Infant wide-field fundus photograph; 1240 x 1240 pixels:
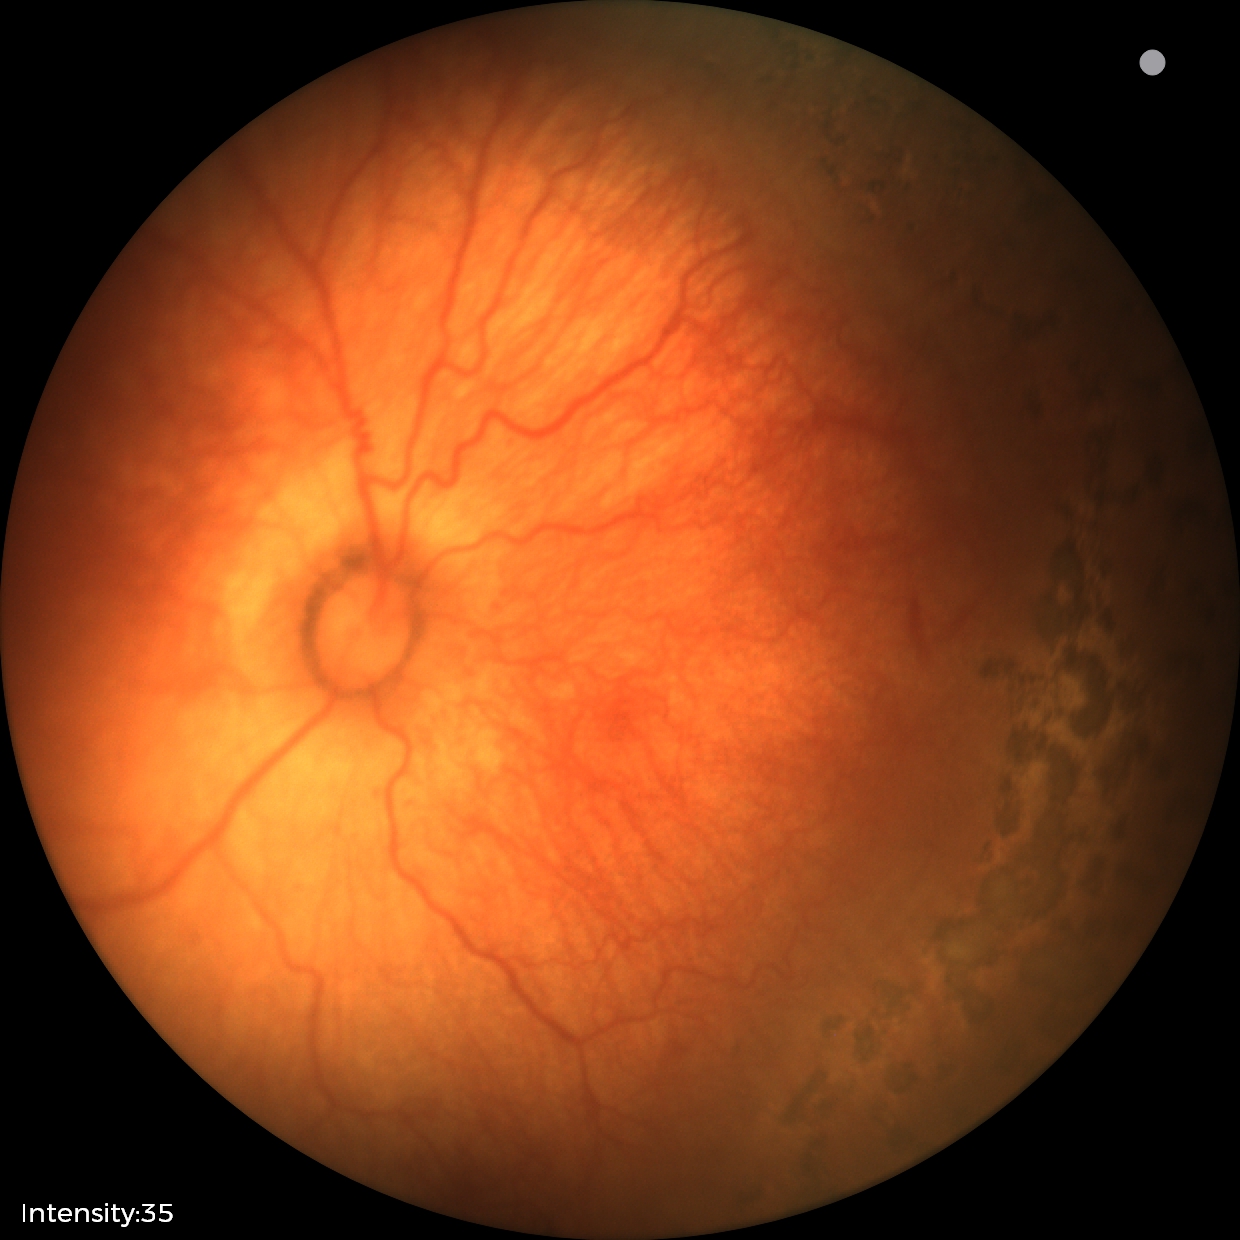

Plus disease present.
From an examination with diagnosis of retinopathy of prematurity (ROP) stage 1 — demarcation line between vascular and avascular retina.